640x480px. Wide-field fundus photograph from neonatal ROP screening
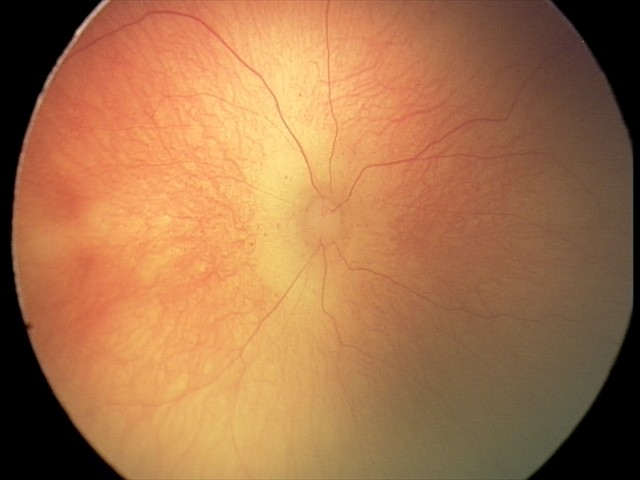 No plus disease.
Examination diagnosed as retinopathy of prematurity stage 0.